Image size 1240x1240; infant wide-field retinal image
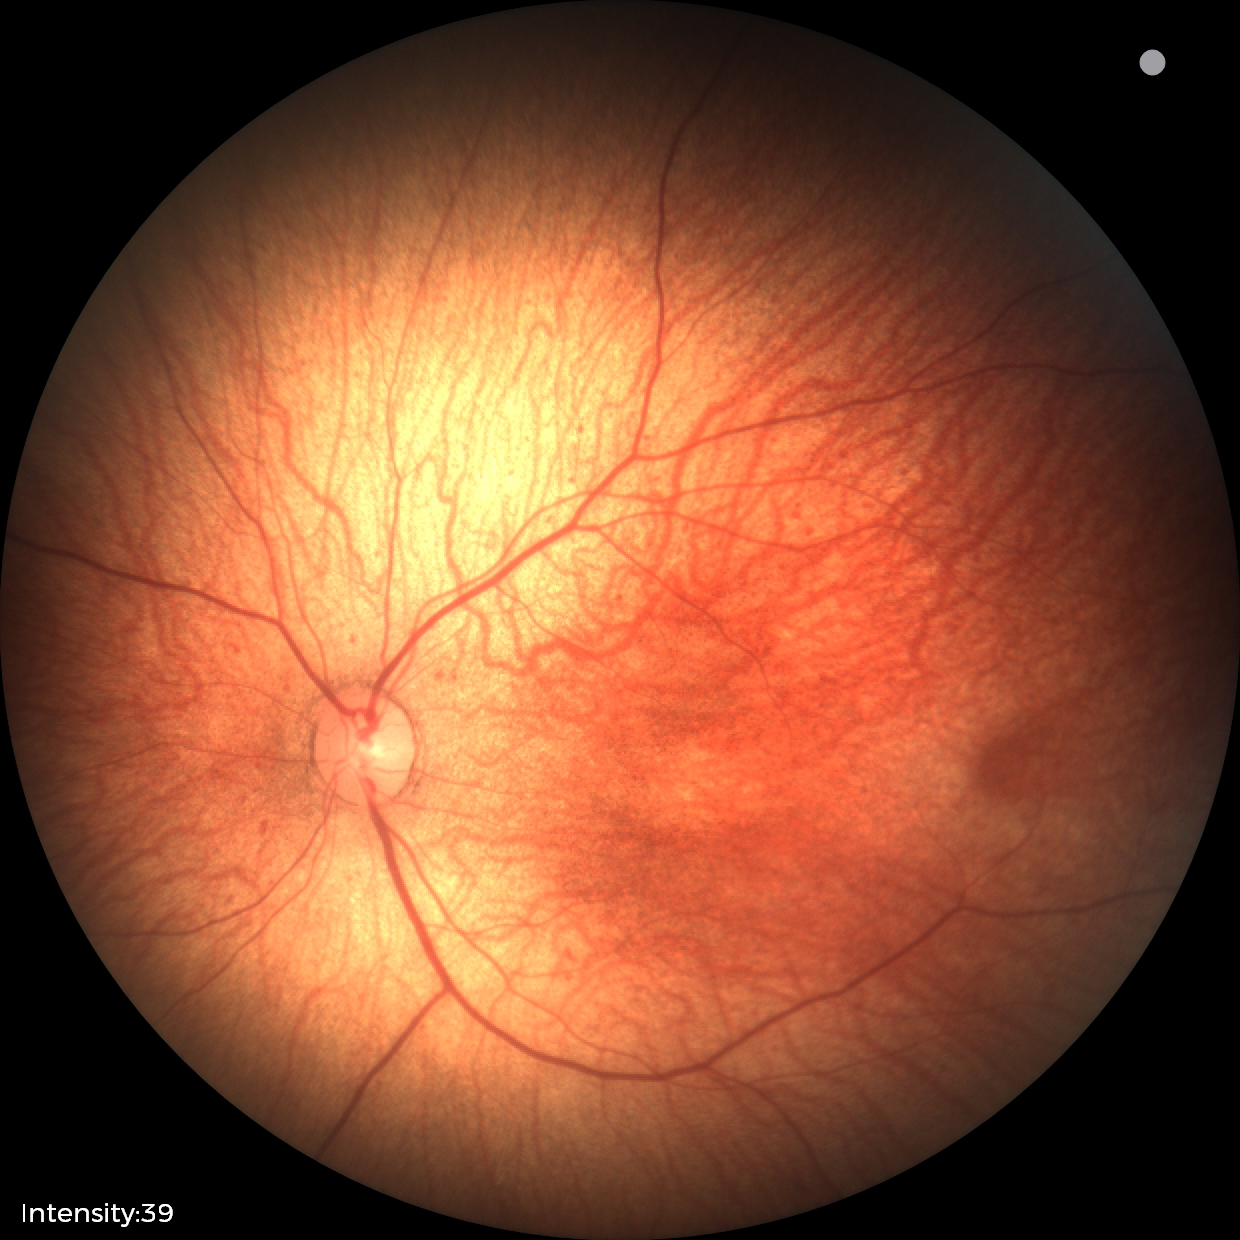

Normal screening examination.